Color fundus photograph — 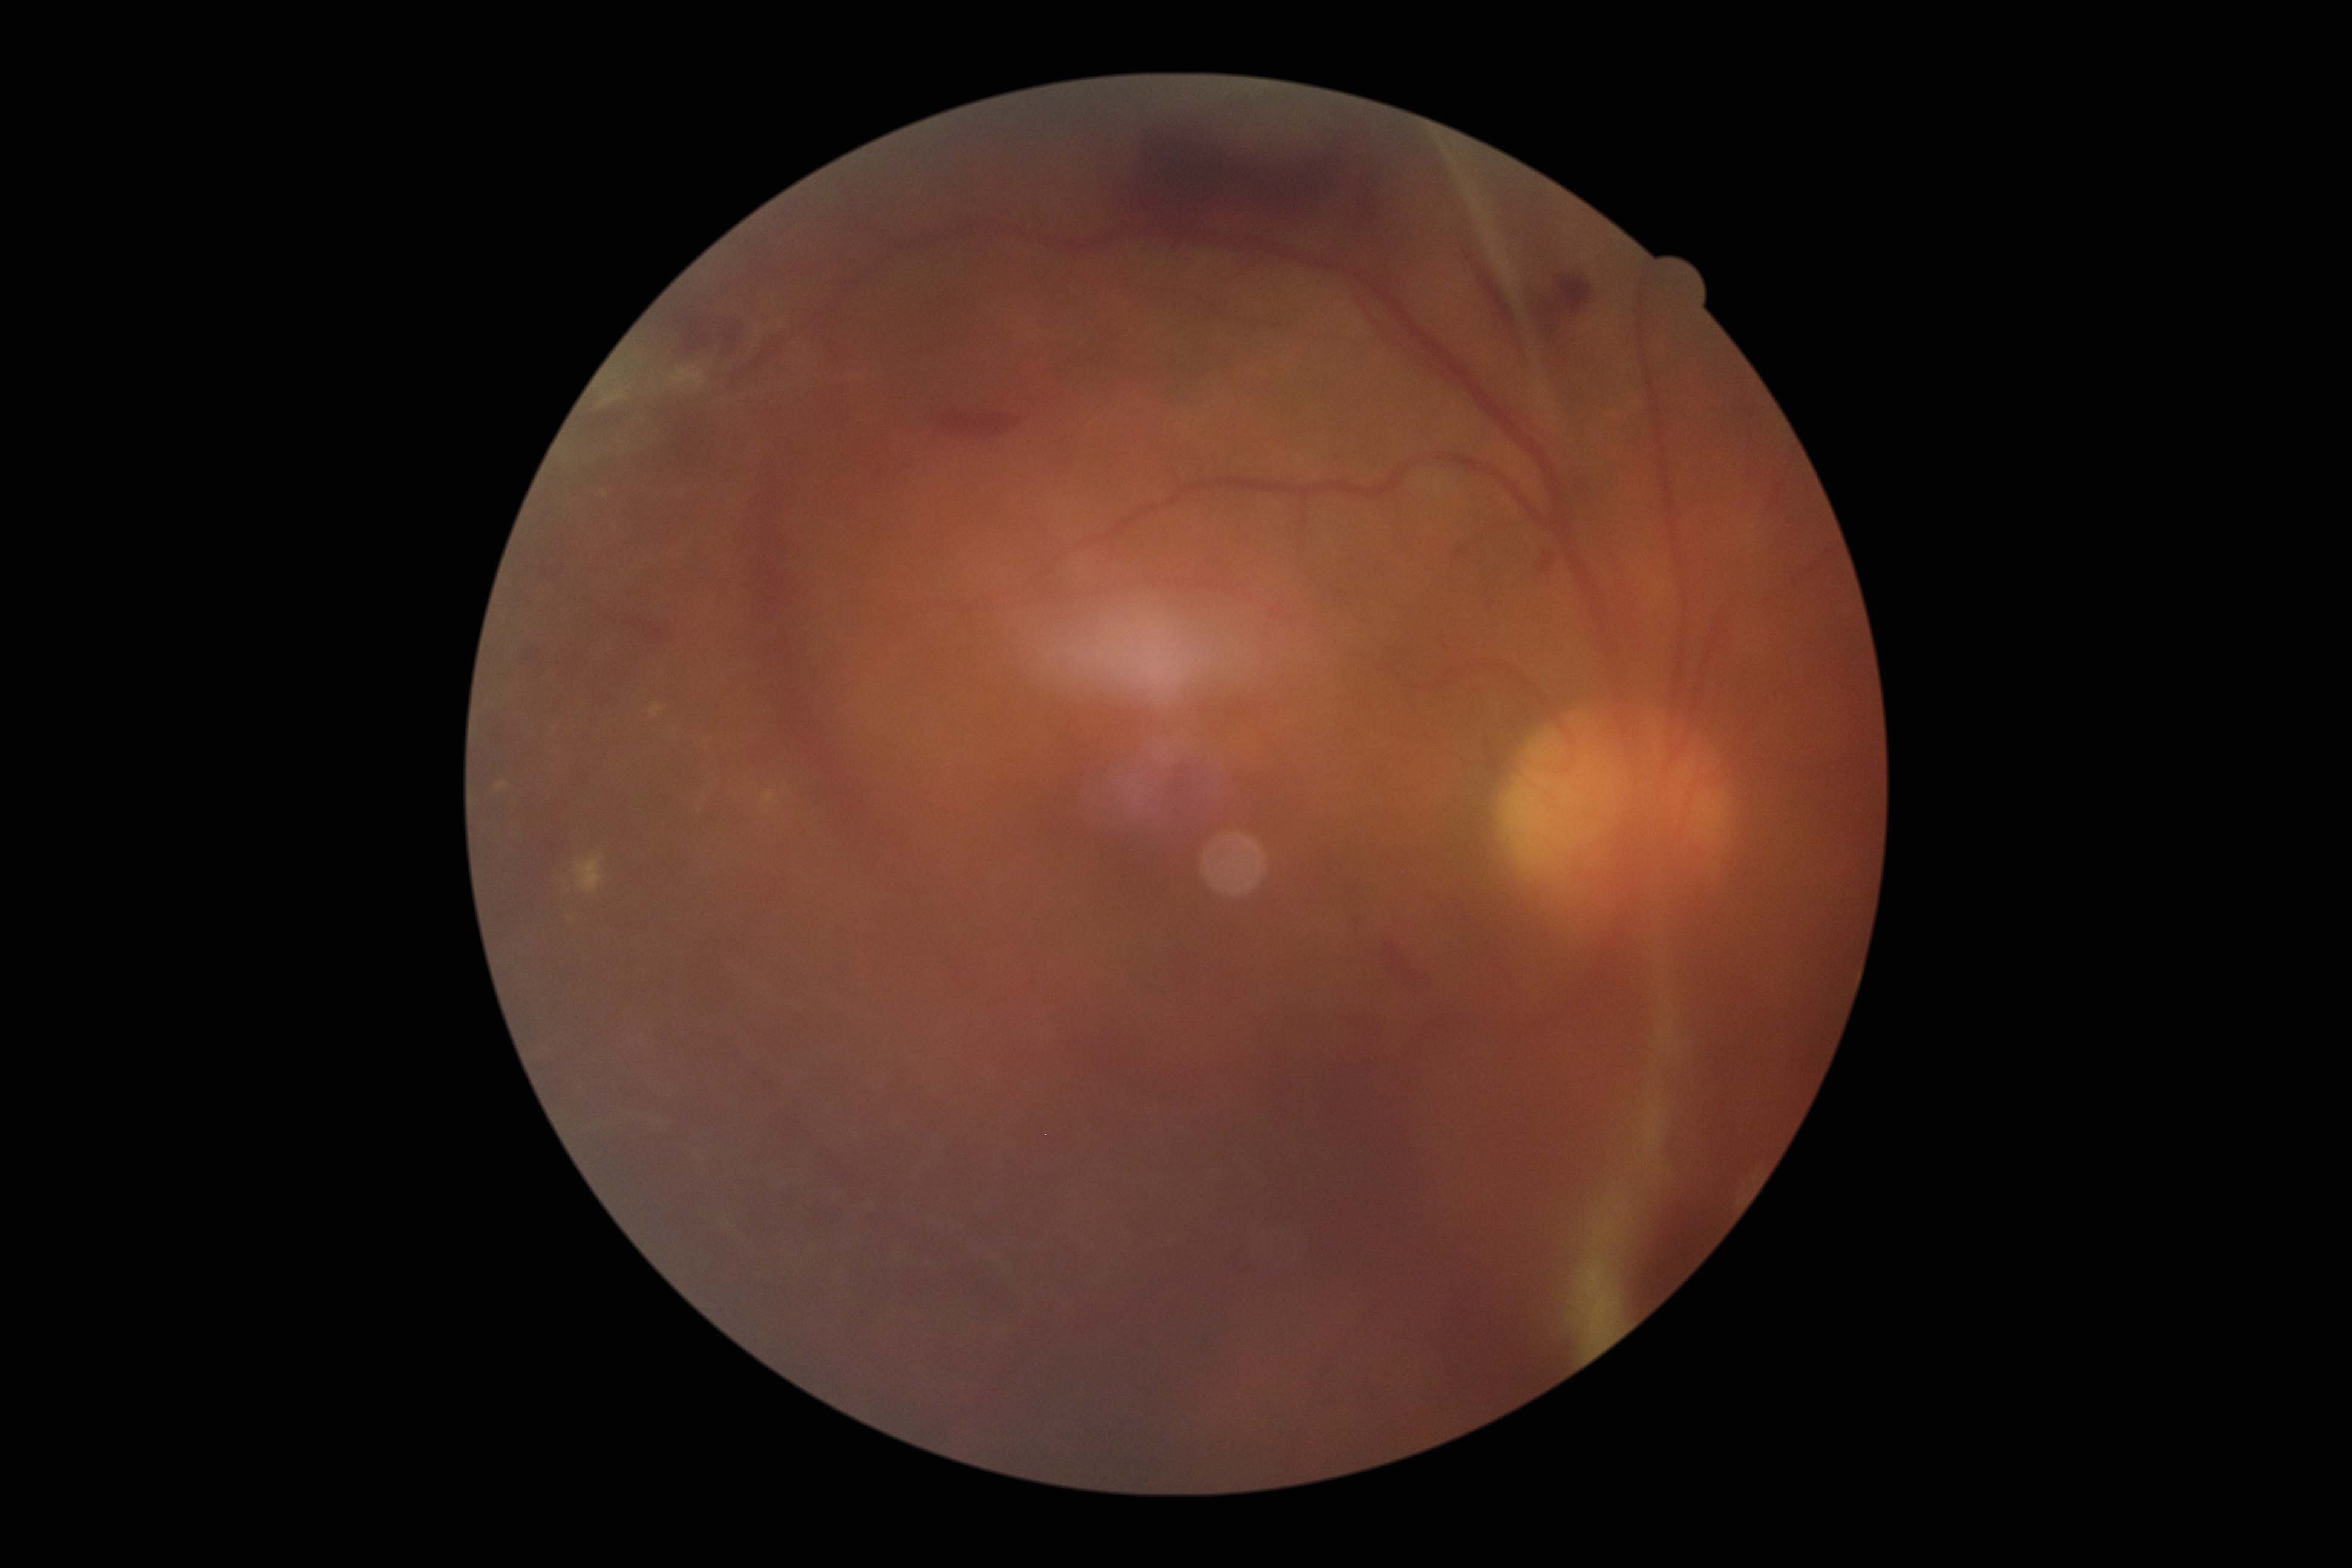
DR grade: 4; DR class: proliferative diabetic retinopathy.